Color fundus photograph. 1659 by 2212 pixels.
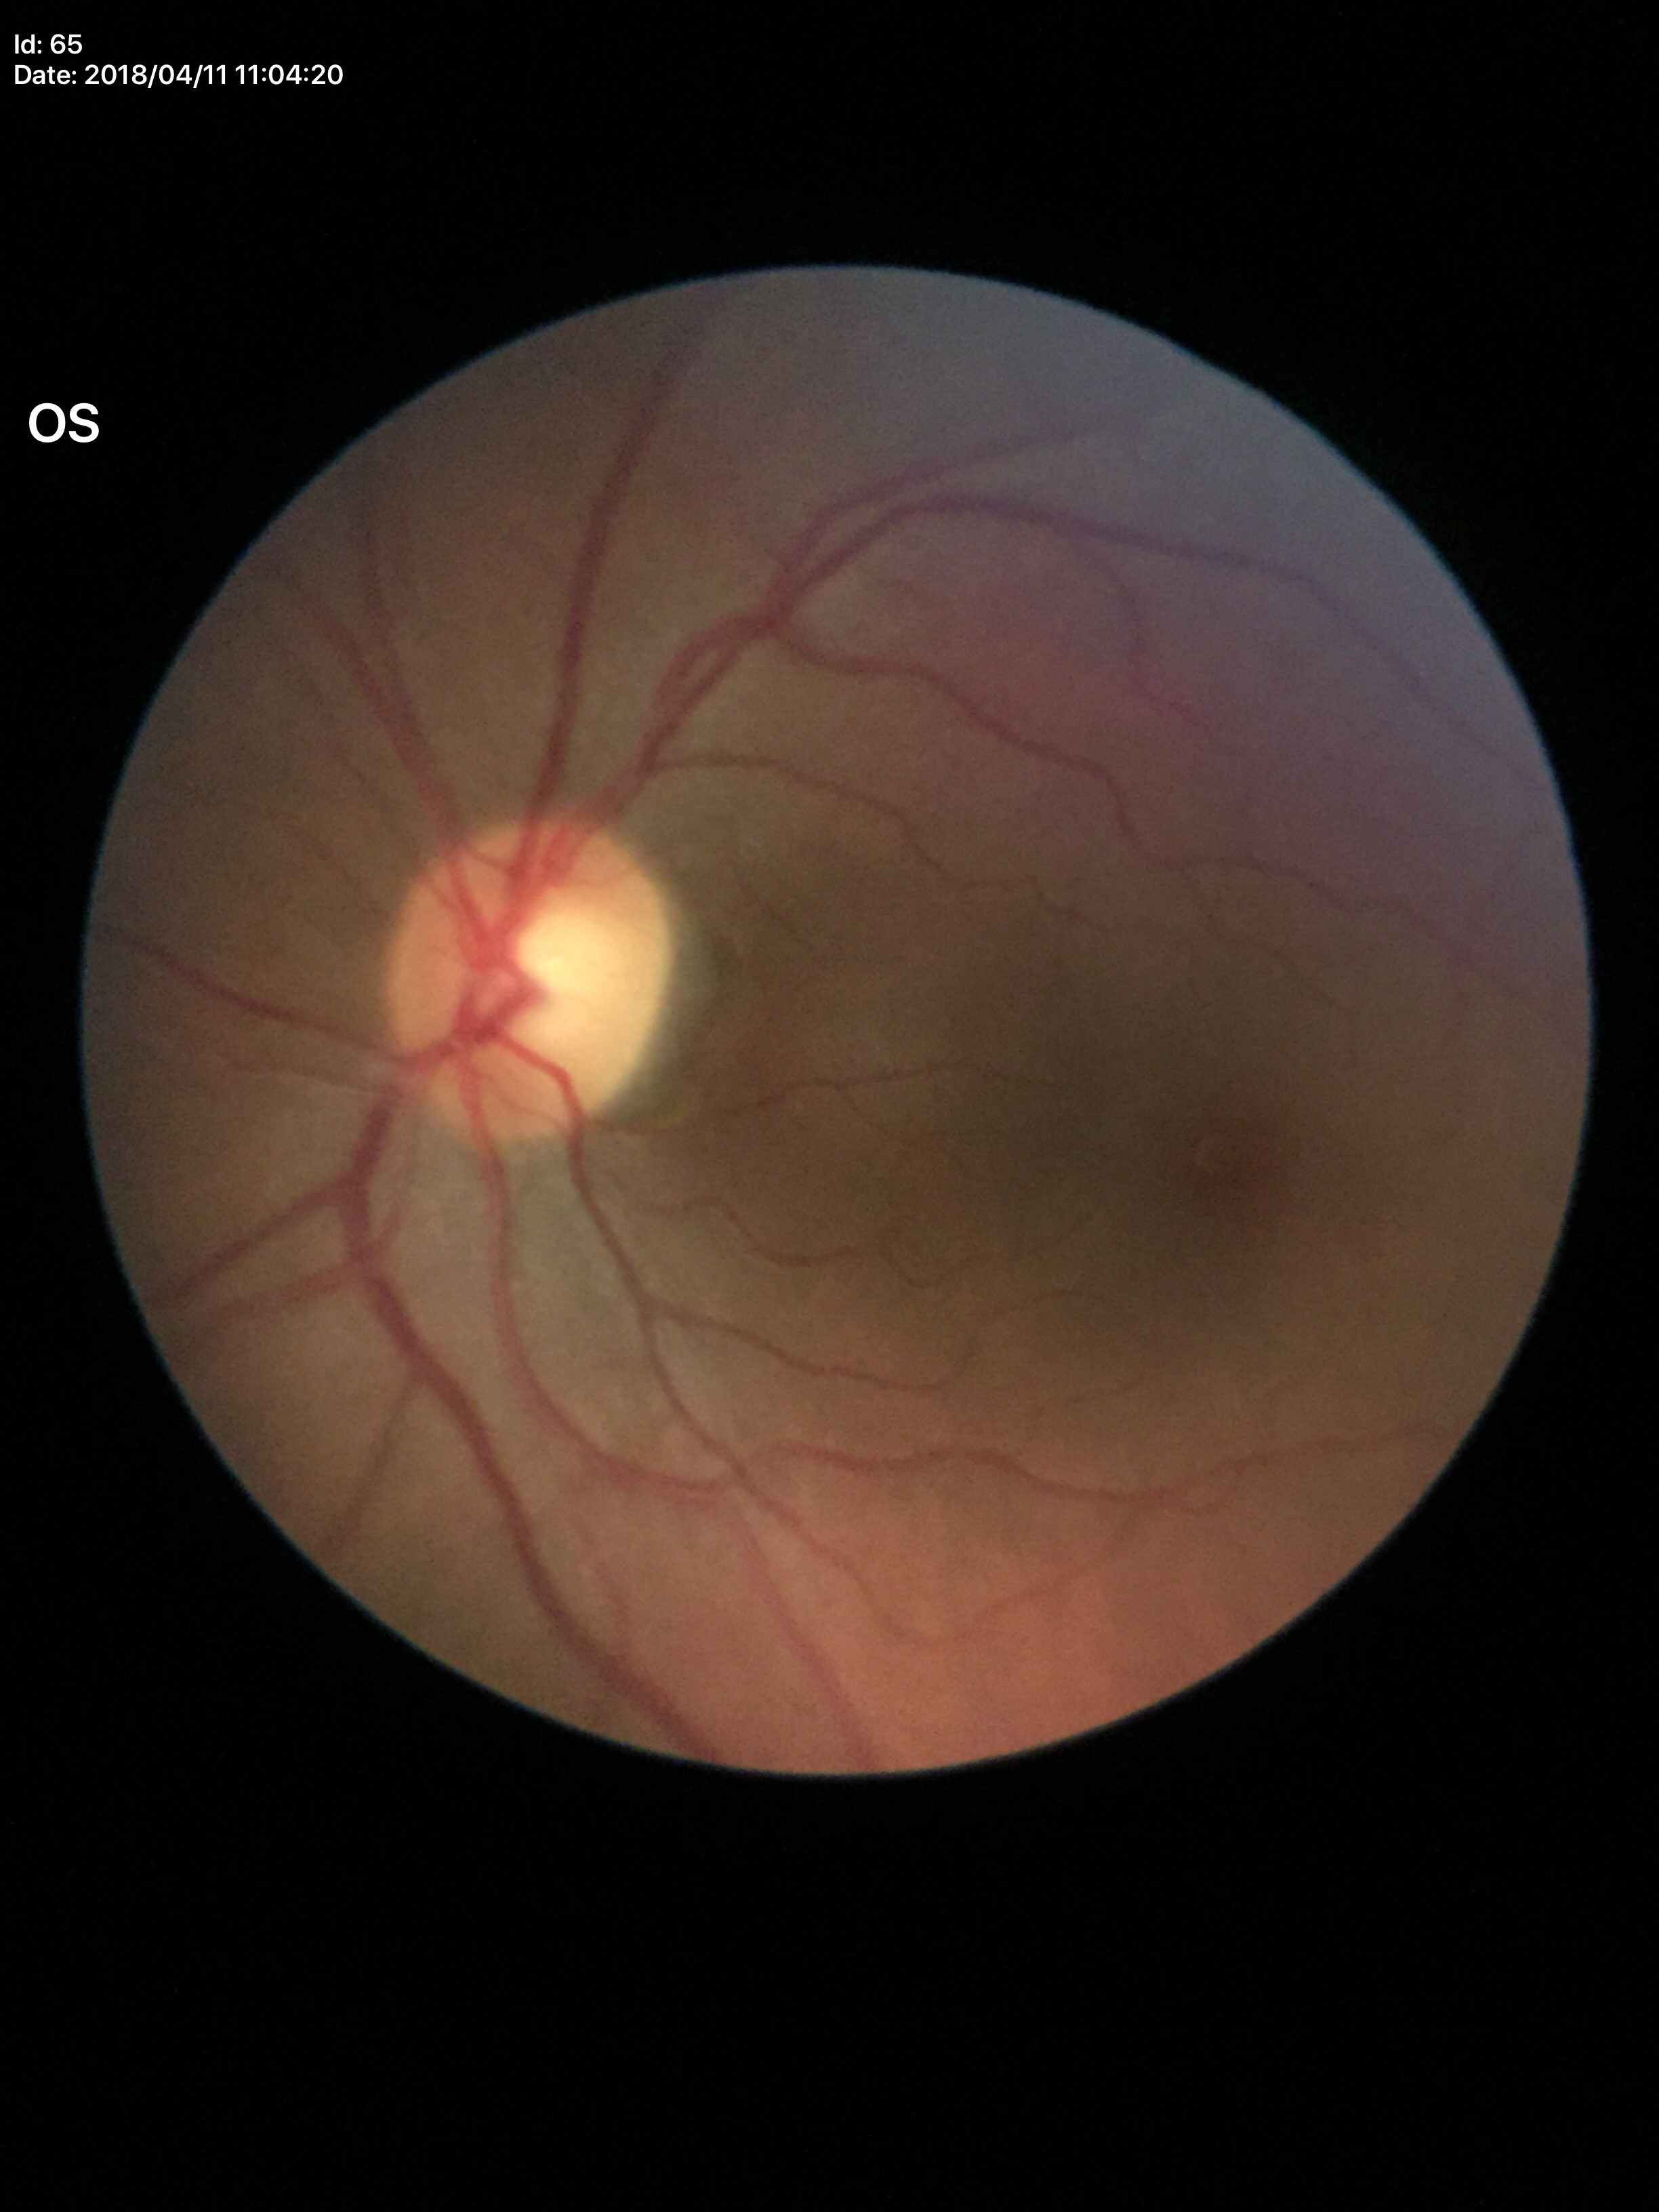
Glaucoma impression: not suspect.
Vertical C/D ratio (VCDR) of 0.60.
Horizontal cup-disc ratio (HCDR) is 0.55.